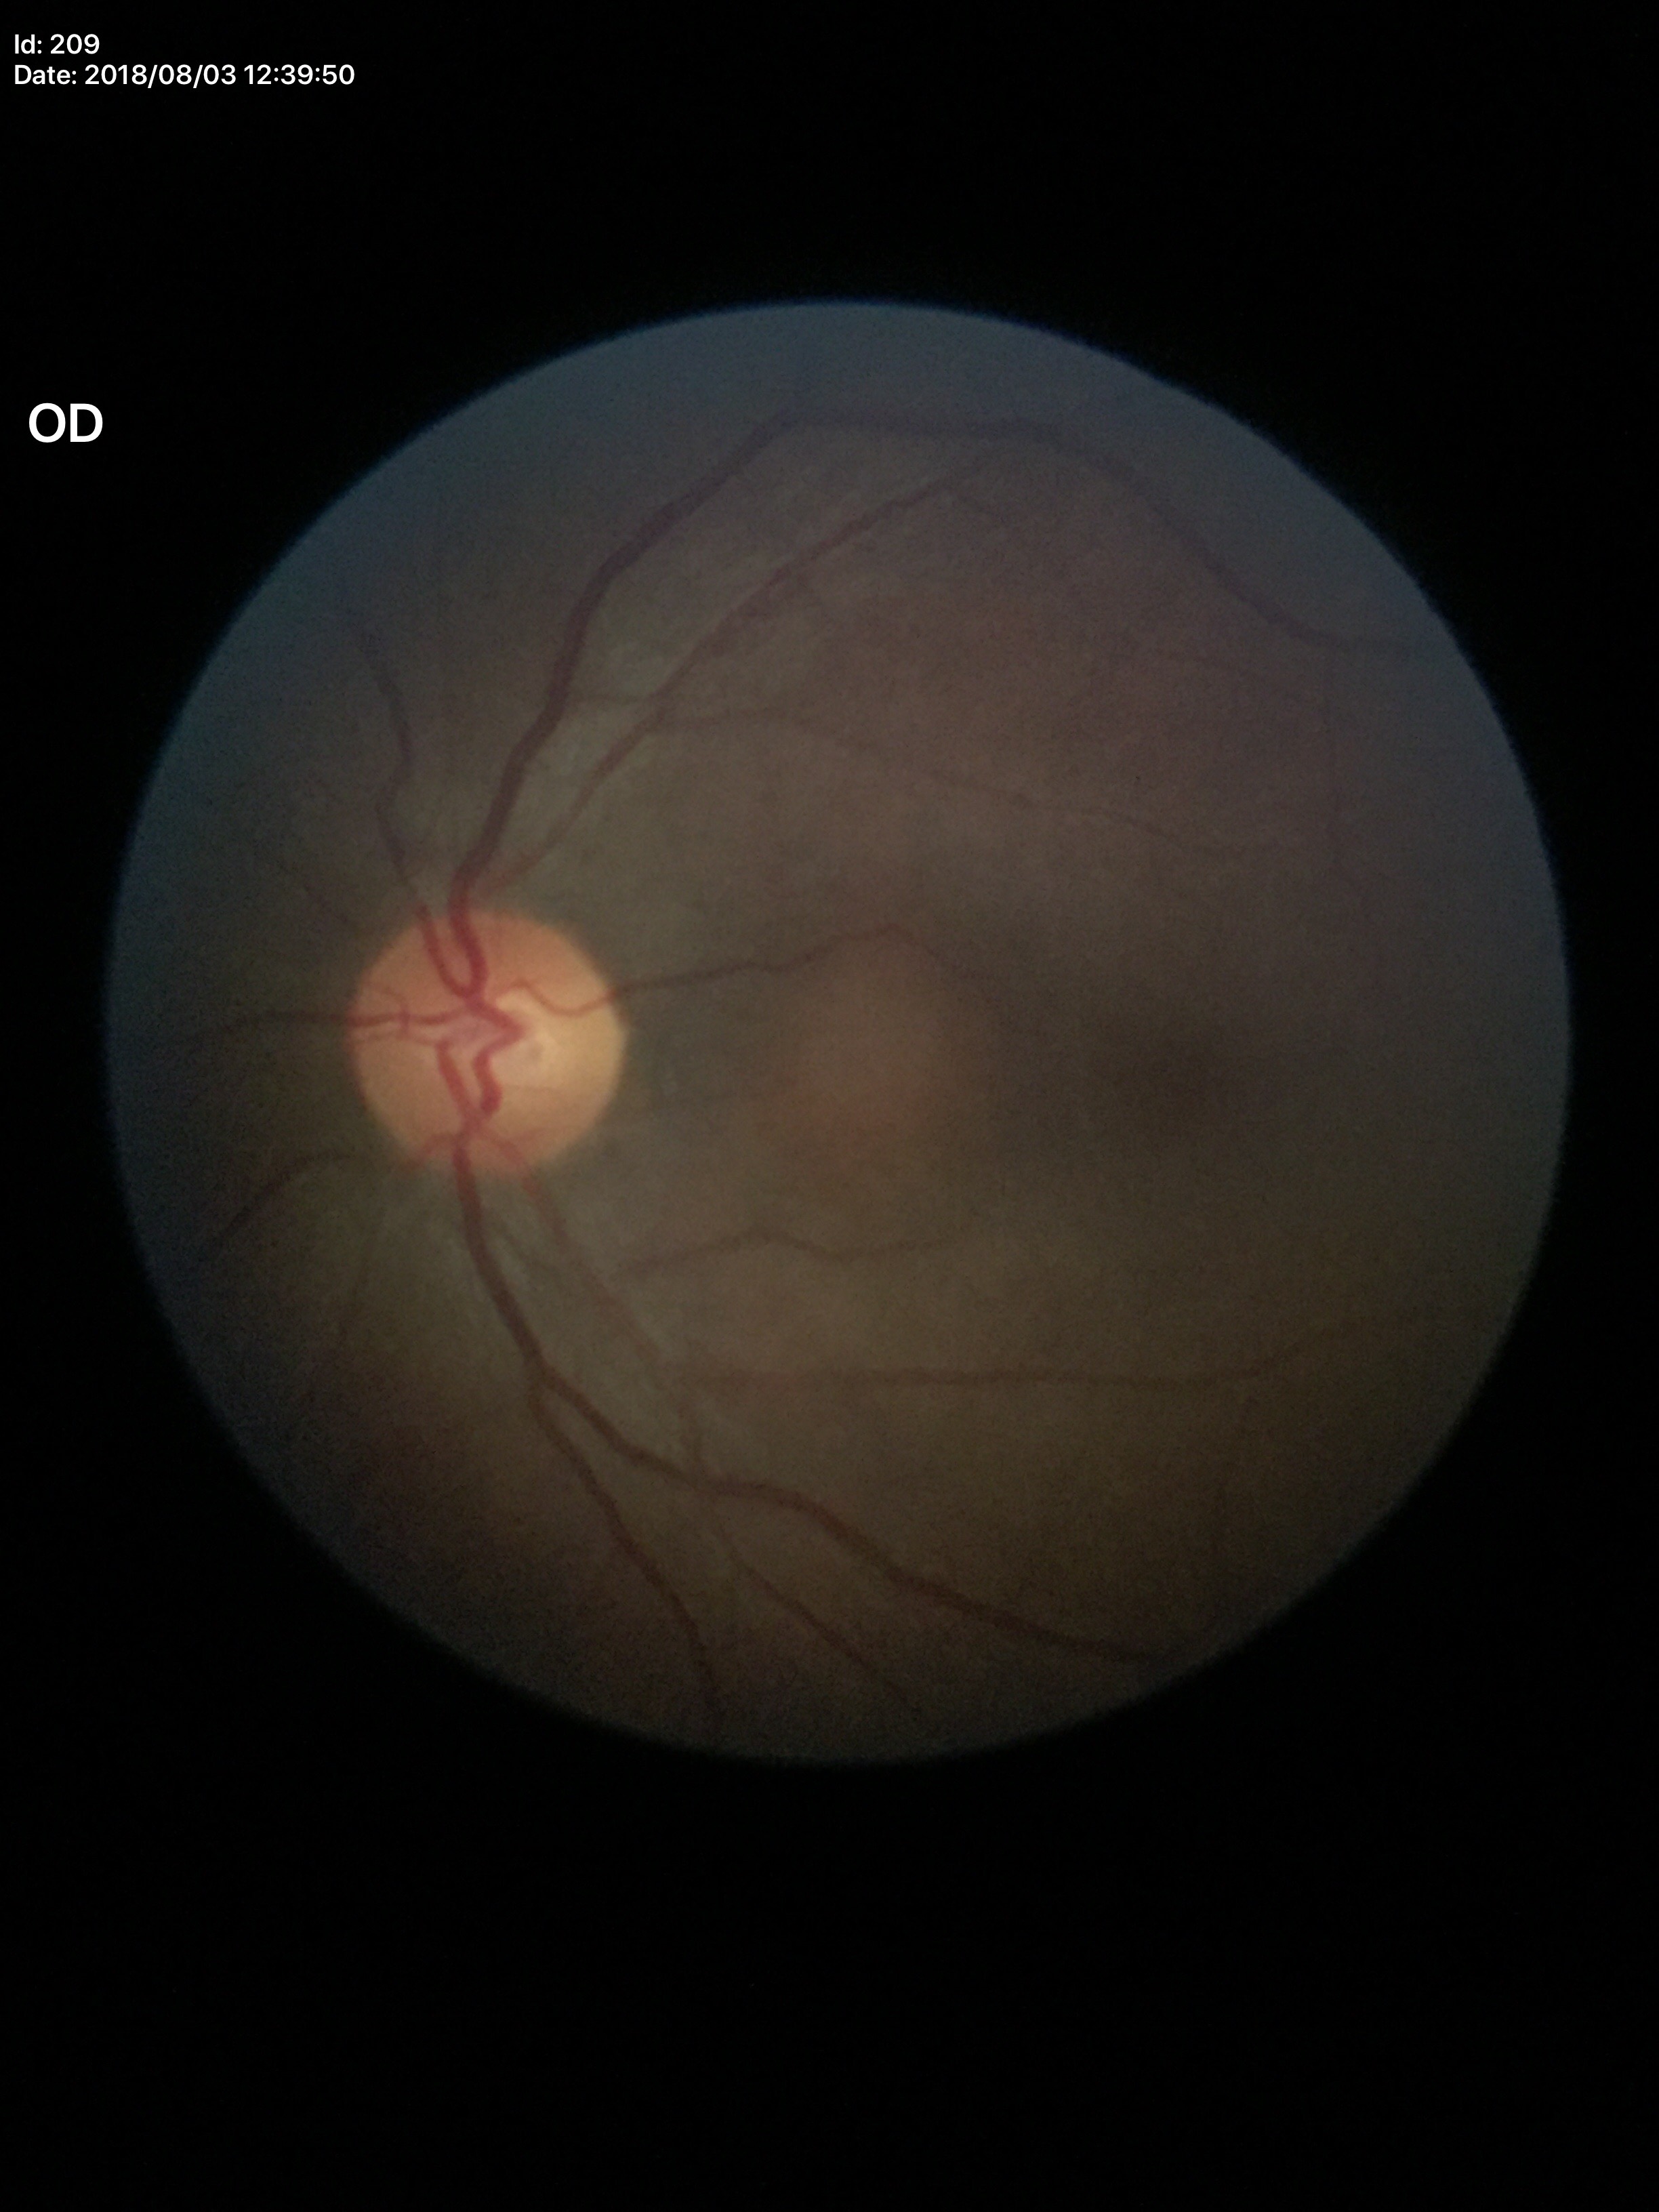
Glaucoma screening impression: not suspect. Vertical C/D ratio is 0.48. Horizontal cup-disc ratio: 0.49.